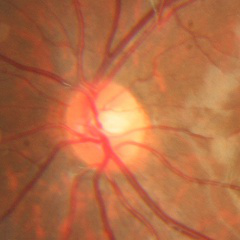

The image shows no glaucomatous changes.